Optic disc region crop · 240 by 240 pixels
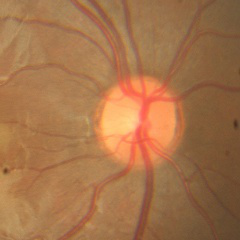

Q: Glaucoma assessment?
A: No glaucoma.